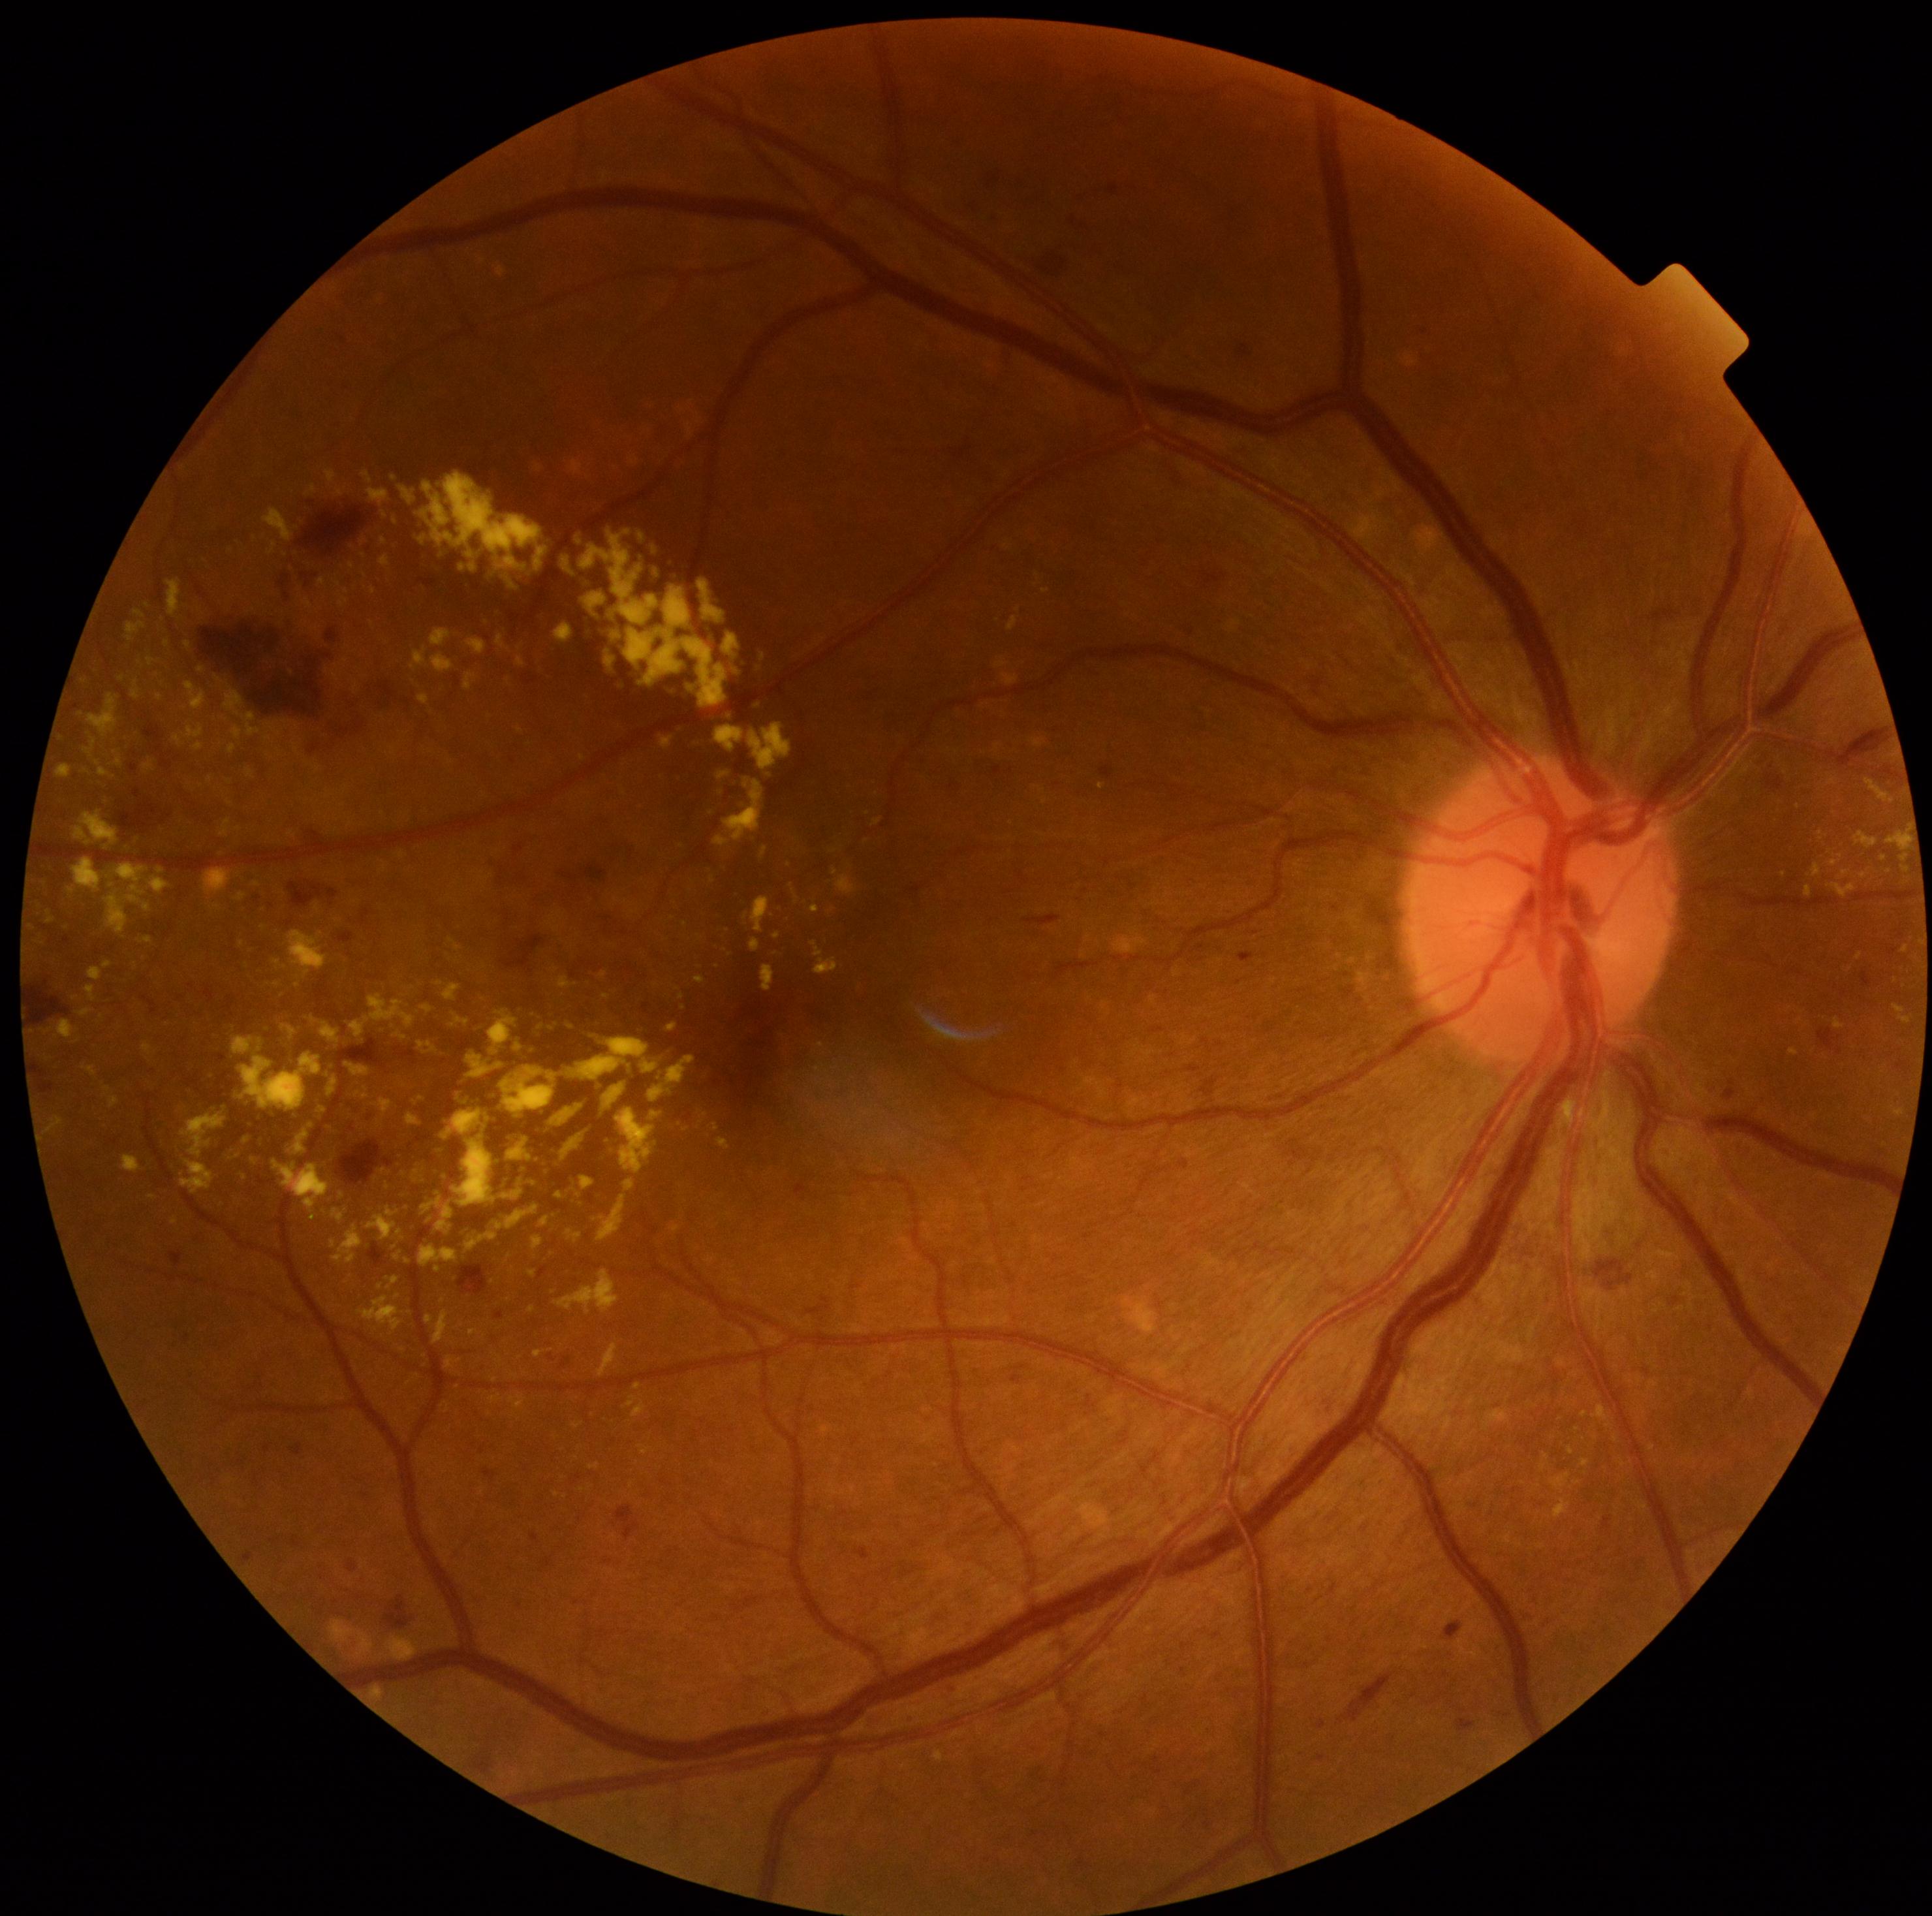 {"partial": true, "dr_grade": 2, "lesions": {"he": [[459, 1264, 489, 1296], [337, 1140, 395, 1186], [298, 507, 369, 558], [559, 870, 580, 881], [354, 719, 365, 734], [1200, 571, 1229, 589], [582, 863, 608, 883], [339, 1038, 387, 1073], [378, 702, 386, 710], [1038, 253, 1068, 277], [32, 986, 71, 1025], [570, 610, 678, 723]], "ma": [[1725, 1081, 1738, 1099], [1318, 1756, 1326, 1761], [1100, 765, 1113, 781], [1456, 1718, 1477, 1731], [494, 1312, 505, 1320], [541, 1558, 553, 1571], [1861, 971, 1873, 987], [169, 1252, 182, 1268], [290, 1444, 304, 1456], [280, 576, 290, 586], [185, 1334, 190, 1342], [1822, 1028, 1844, 1055], [531, 1534, 541, 1543], [1109, 184, 1119, 196], [130, 765, 138, 772]], "ex": [[84, 738, 116, 779], [639, 533, 646, 541], [110, 1095, 119, 1108], [583, 593, 608, 619], [1553, 1499, 1572, 1518], [630, 907, 639, 915], [181, 995, 416, 1221], [1538, 1545, 1546, 1548], [194, 743, 204, 751], [407, 1112, 421, 1125], [535, 466, 544, 473], [417, 1042, 438, 1055], [612, 632, 622, 641], [625, 1179, 635, 1193]], "ex_small": [[218, 908], [159, 698], [397, 1258], [700, 967], [1543, 1467], [658, 574]]}}